Field includes the optic disc and macula · mydriatic (tropicamide and phenylephrine) · 2228 by 1652 pixels — 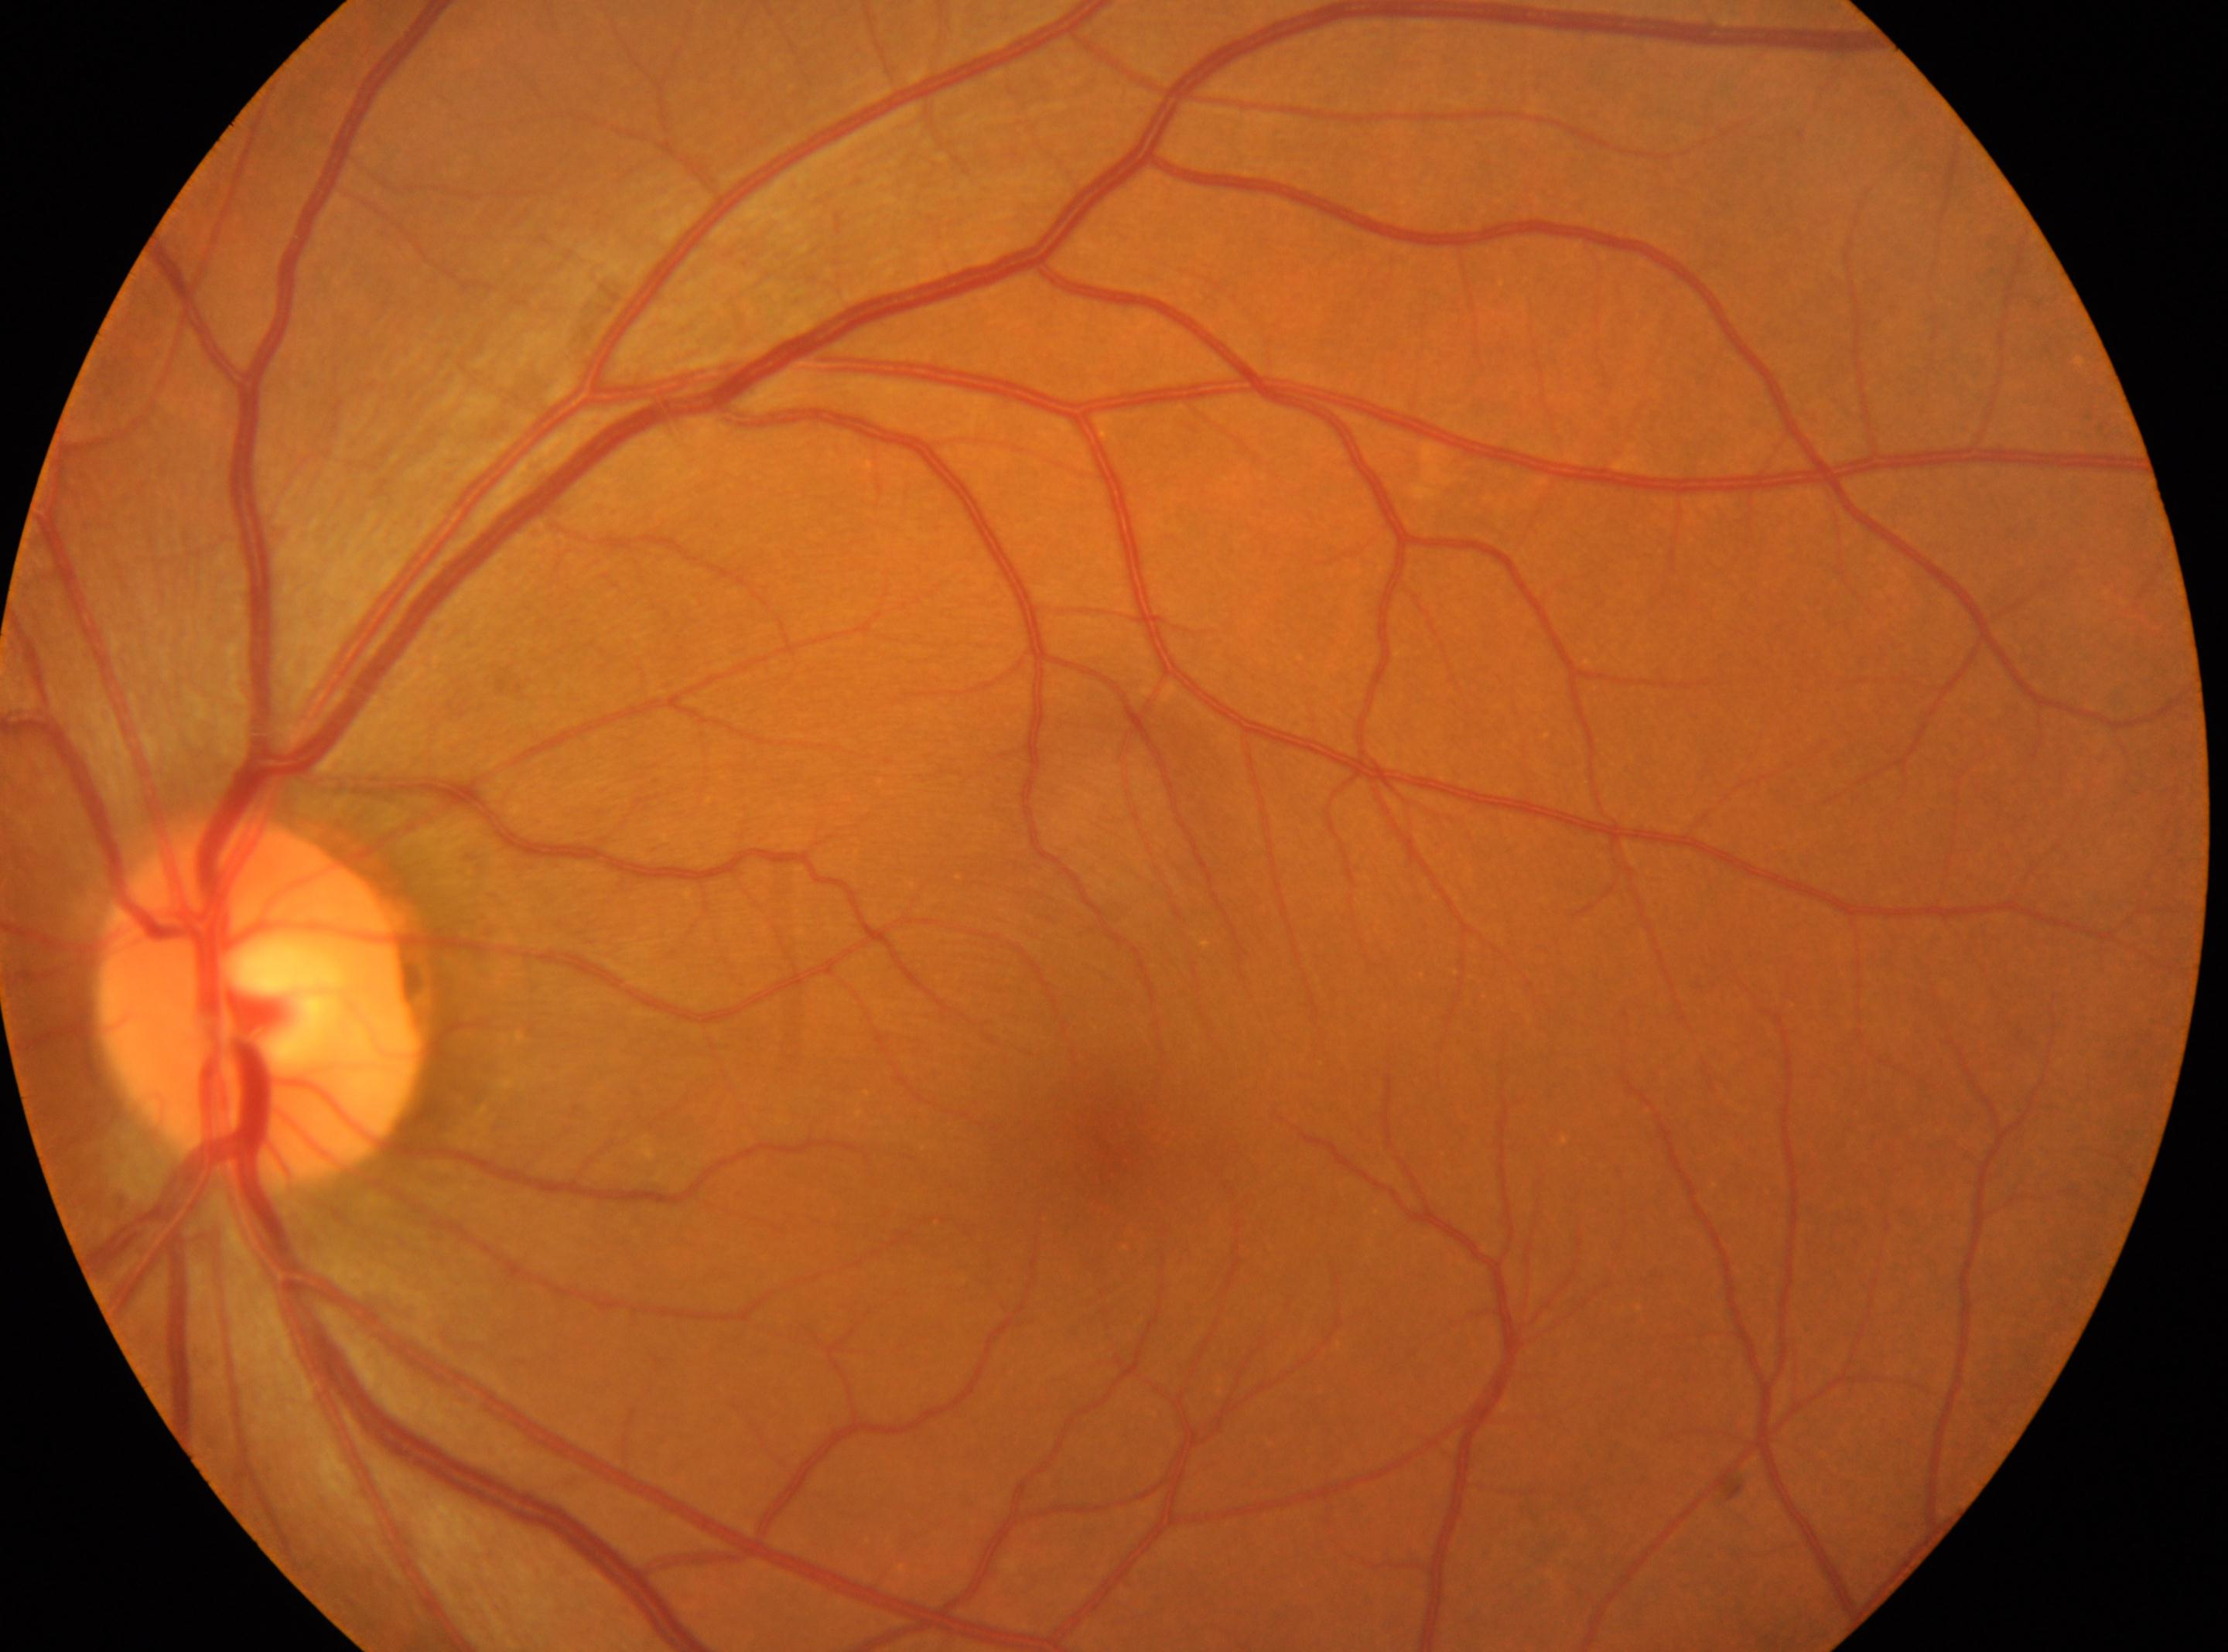
| key | value |
|---|---|
| eye | OS |
| diabetic retinopathy grade | 0 (no apparent retinopathy) |
| DR impression | No DR findings |
| fovea | [1111, 1160] |
| ONH | [258, 998] |